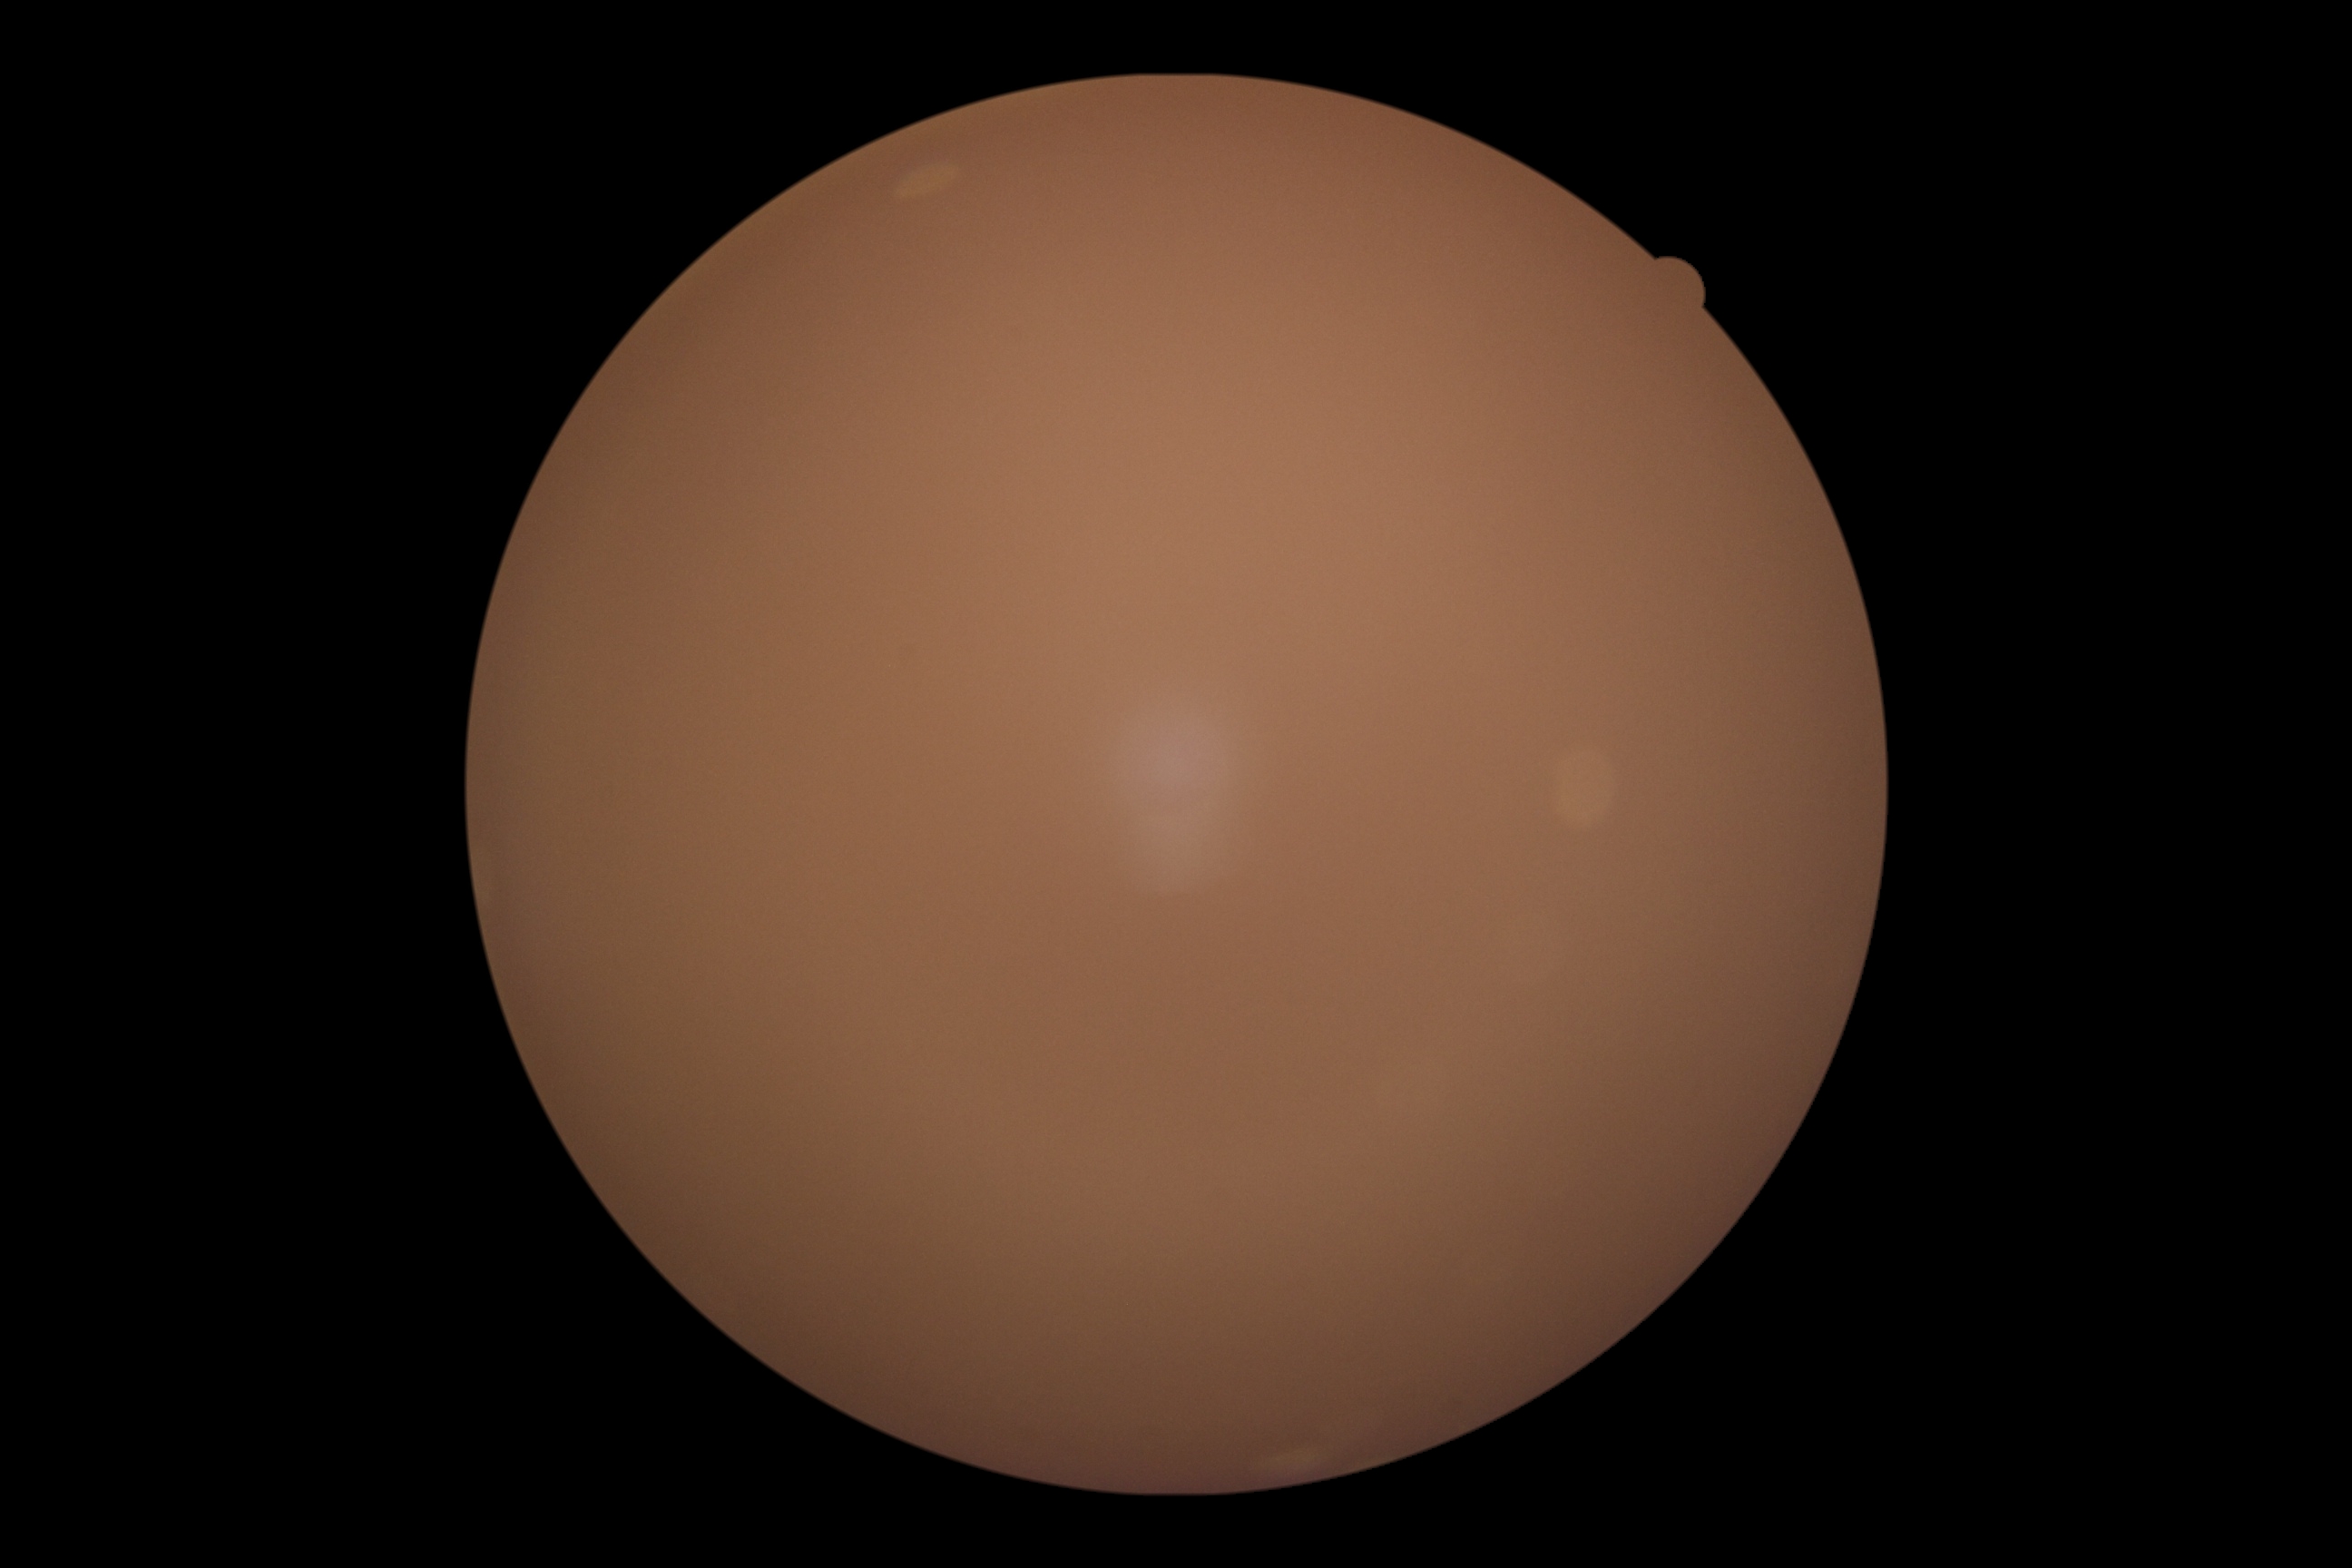

DR grade: ungradable.